Fundus photo. 1470x1137px.
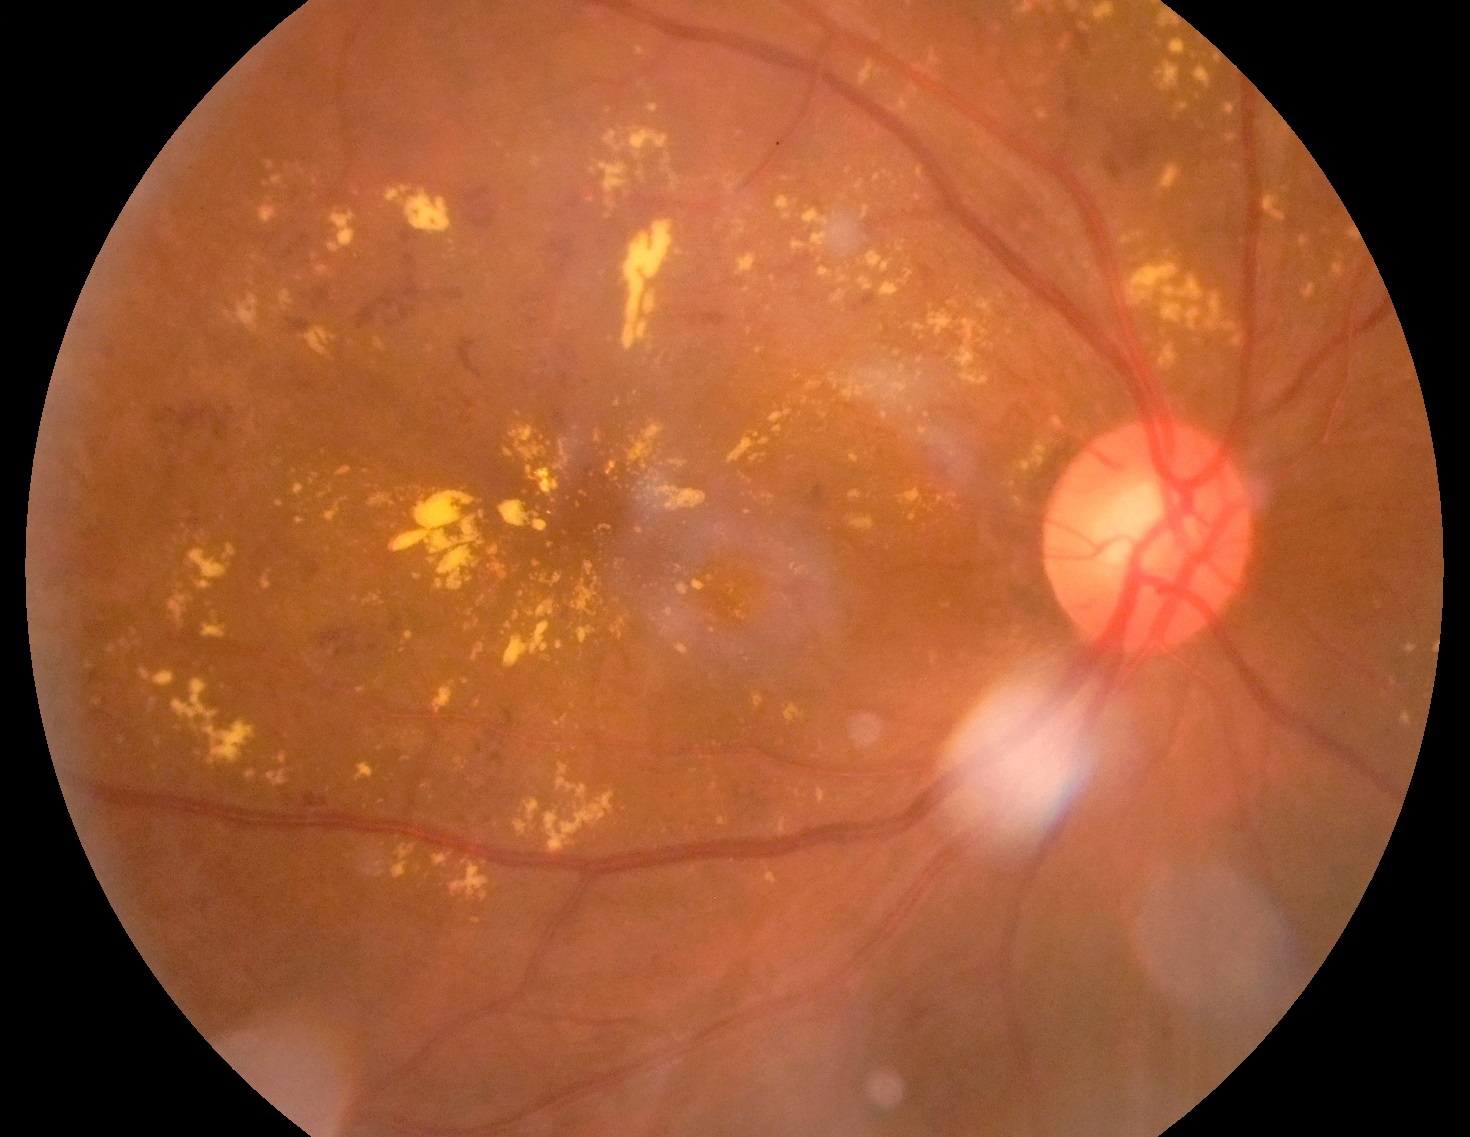
Retinopathy is 2 — more than just microaneurysms but less than severe NPDR.